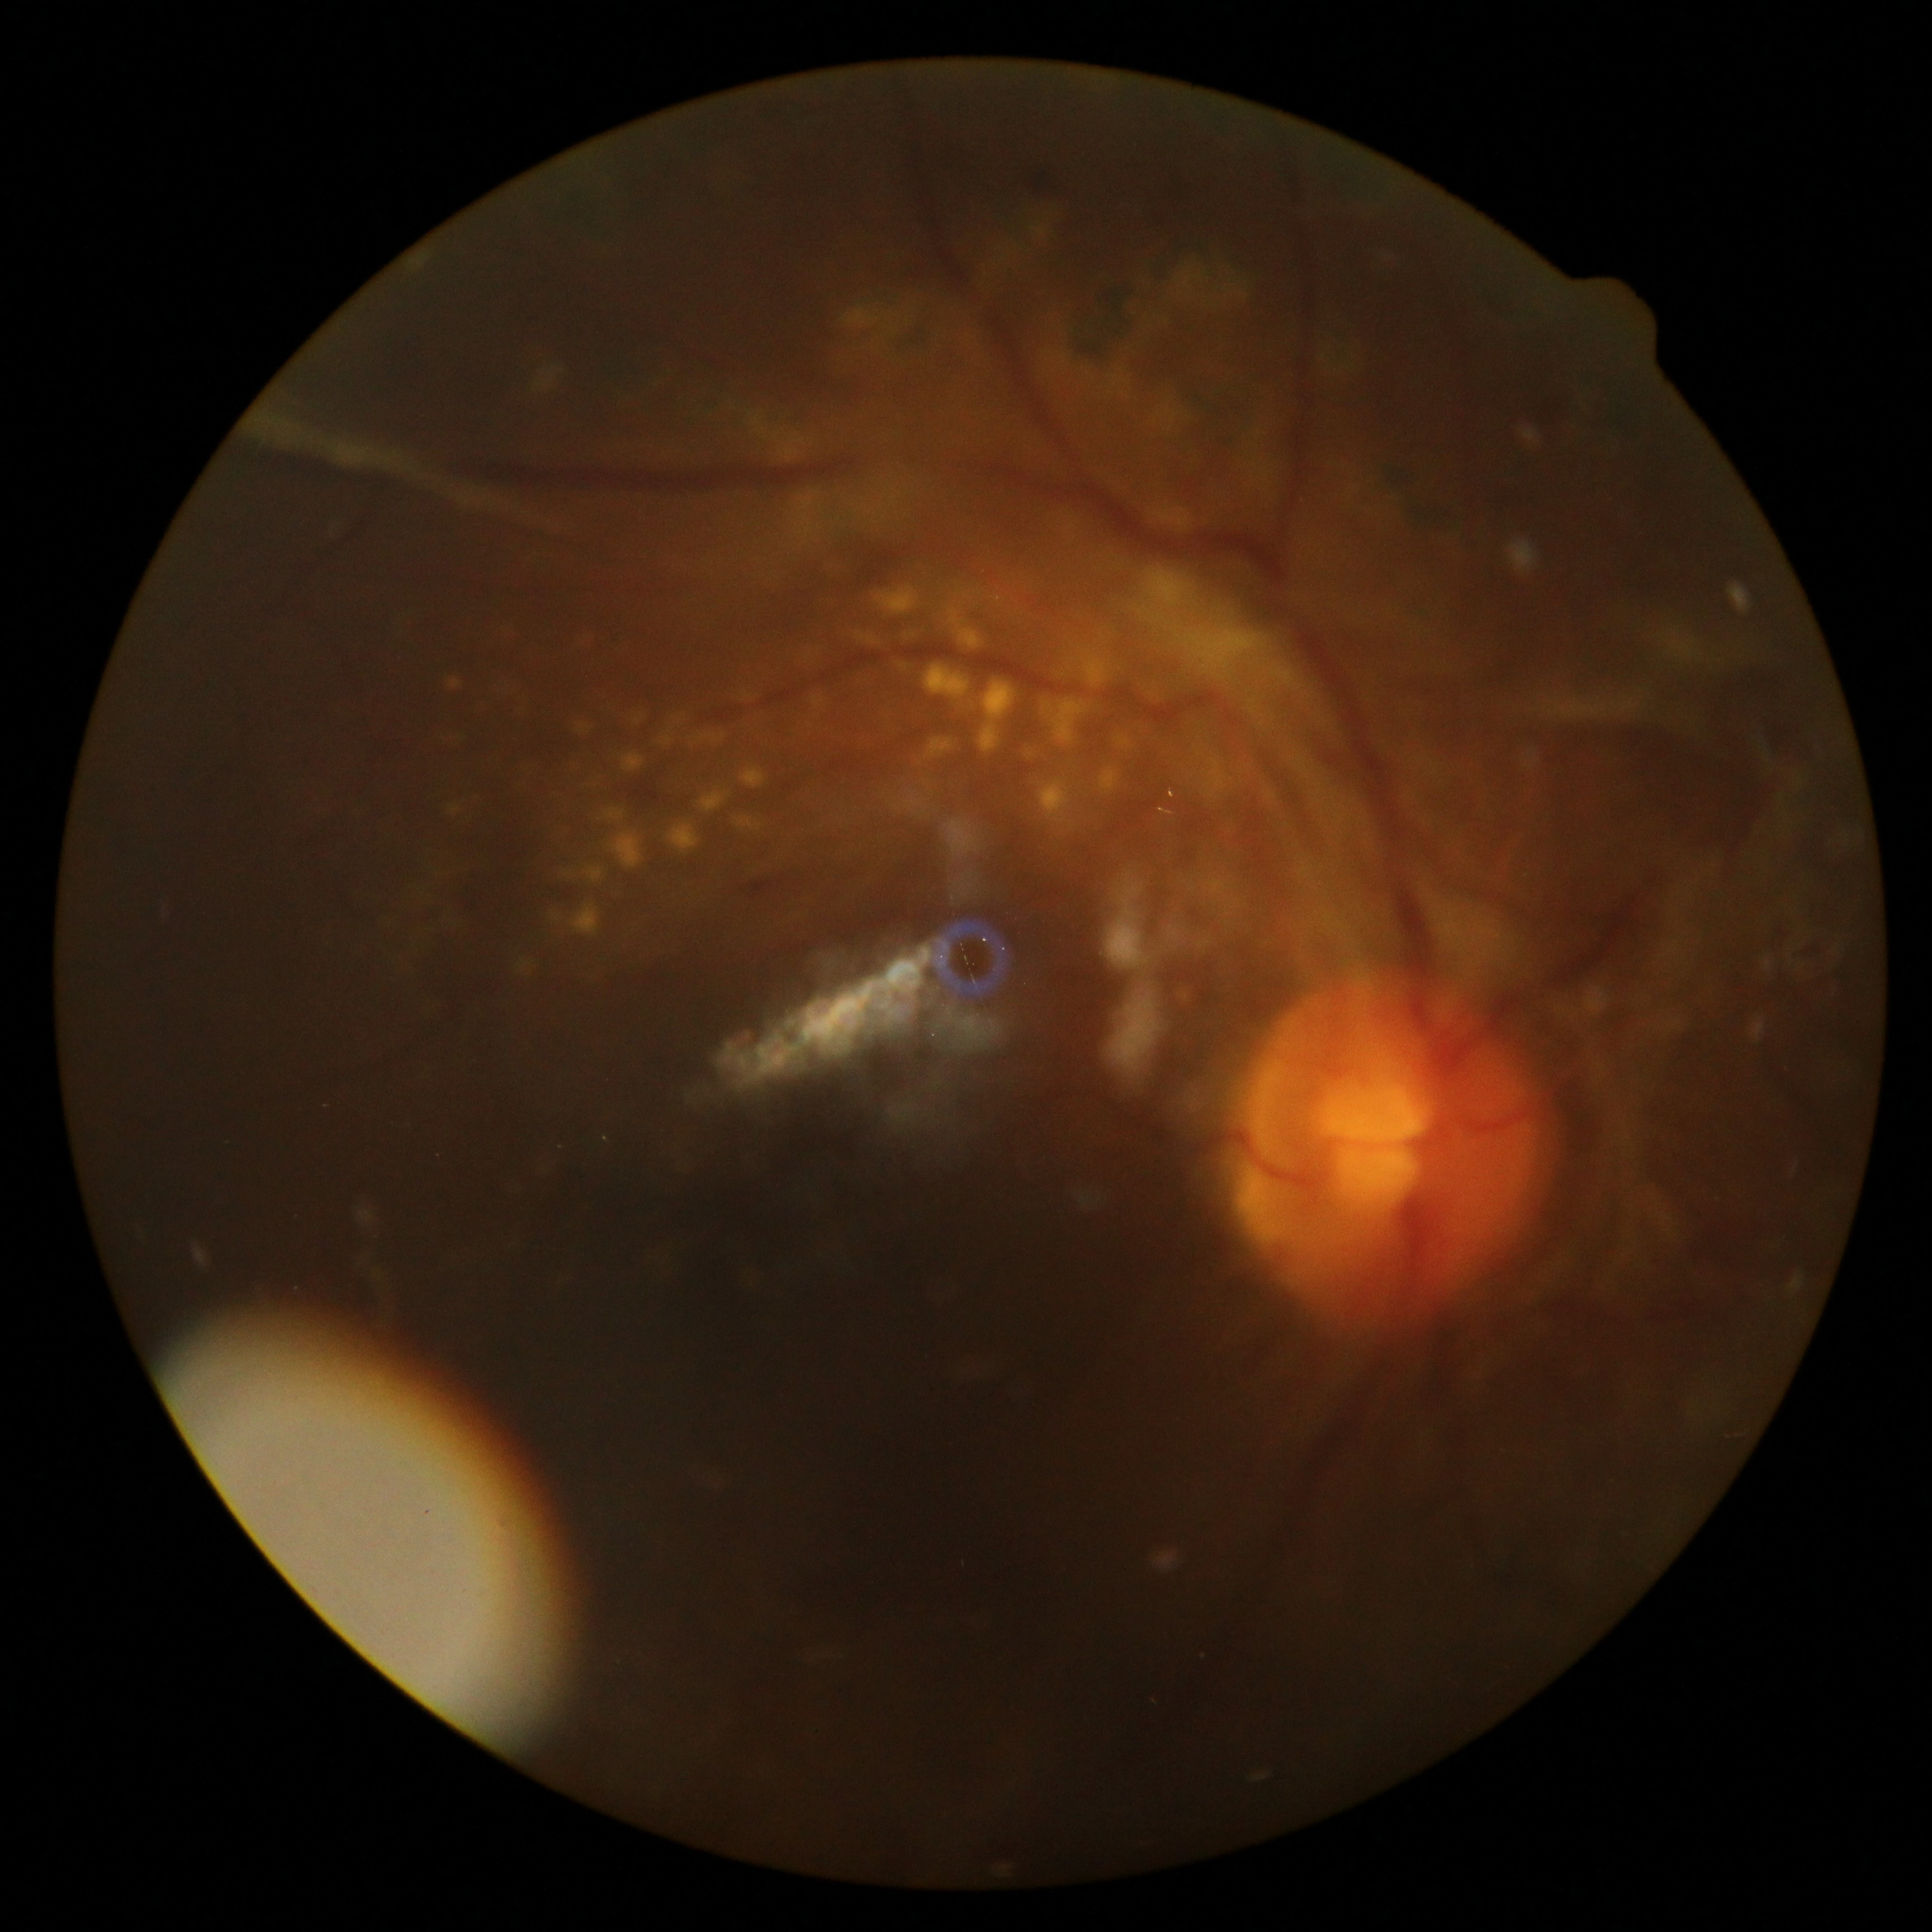

retinopathy: grade 4 (PDR).